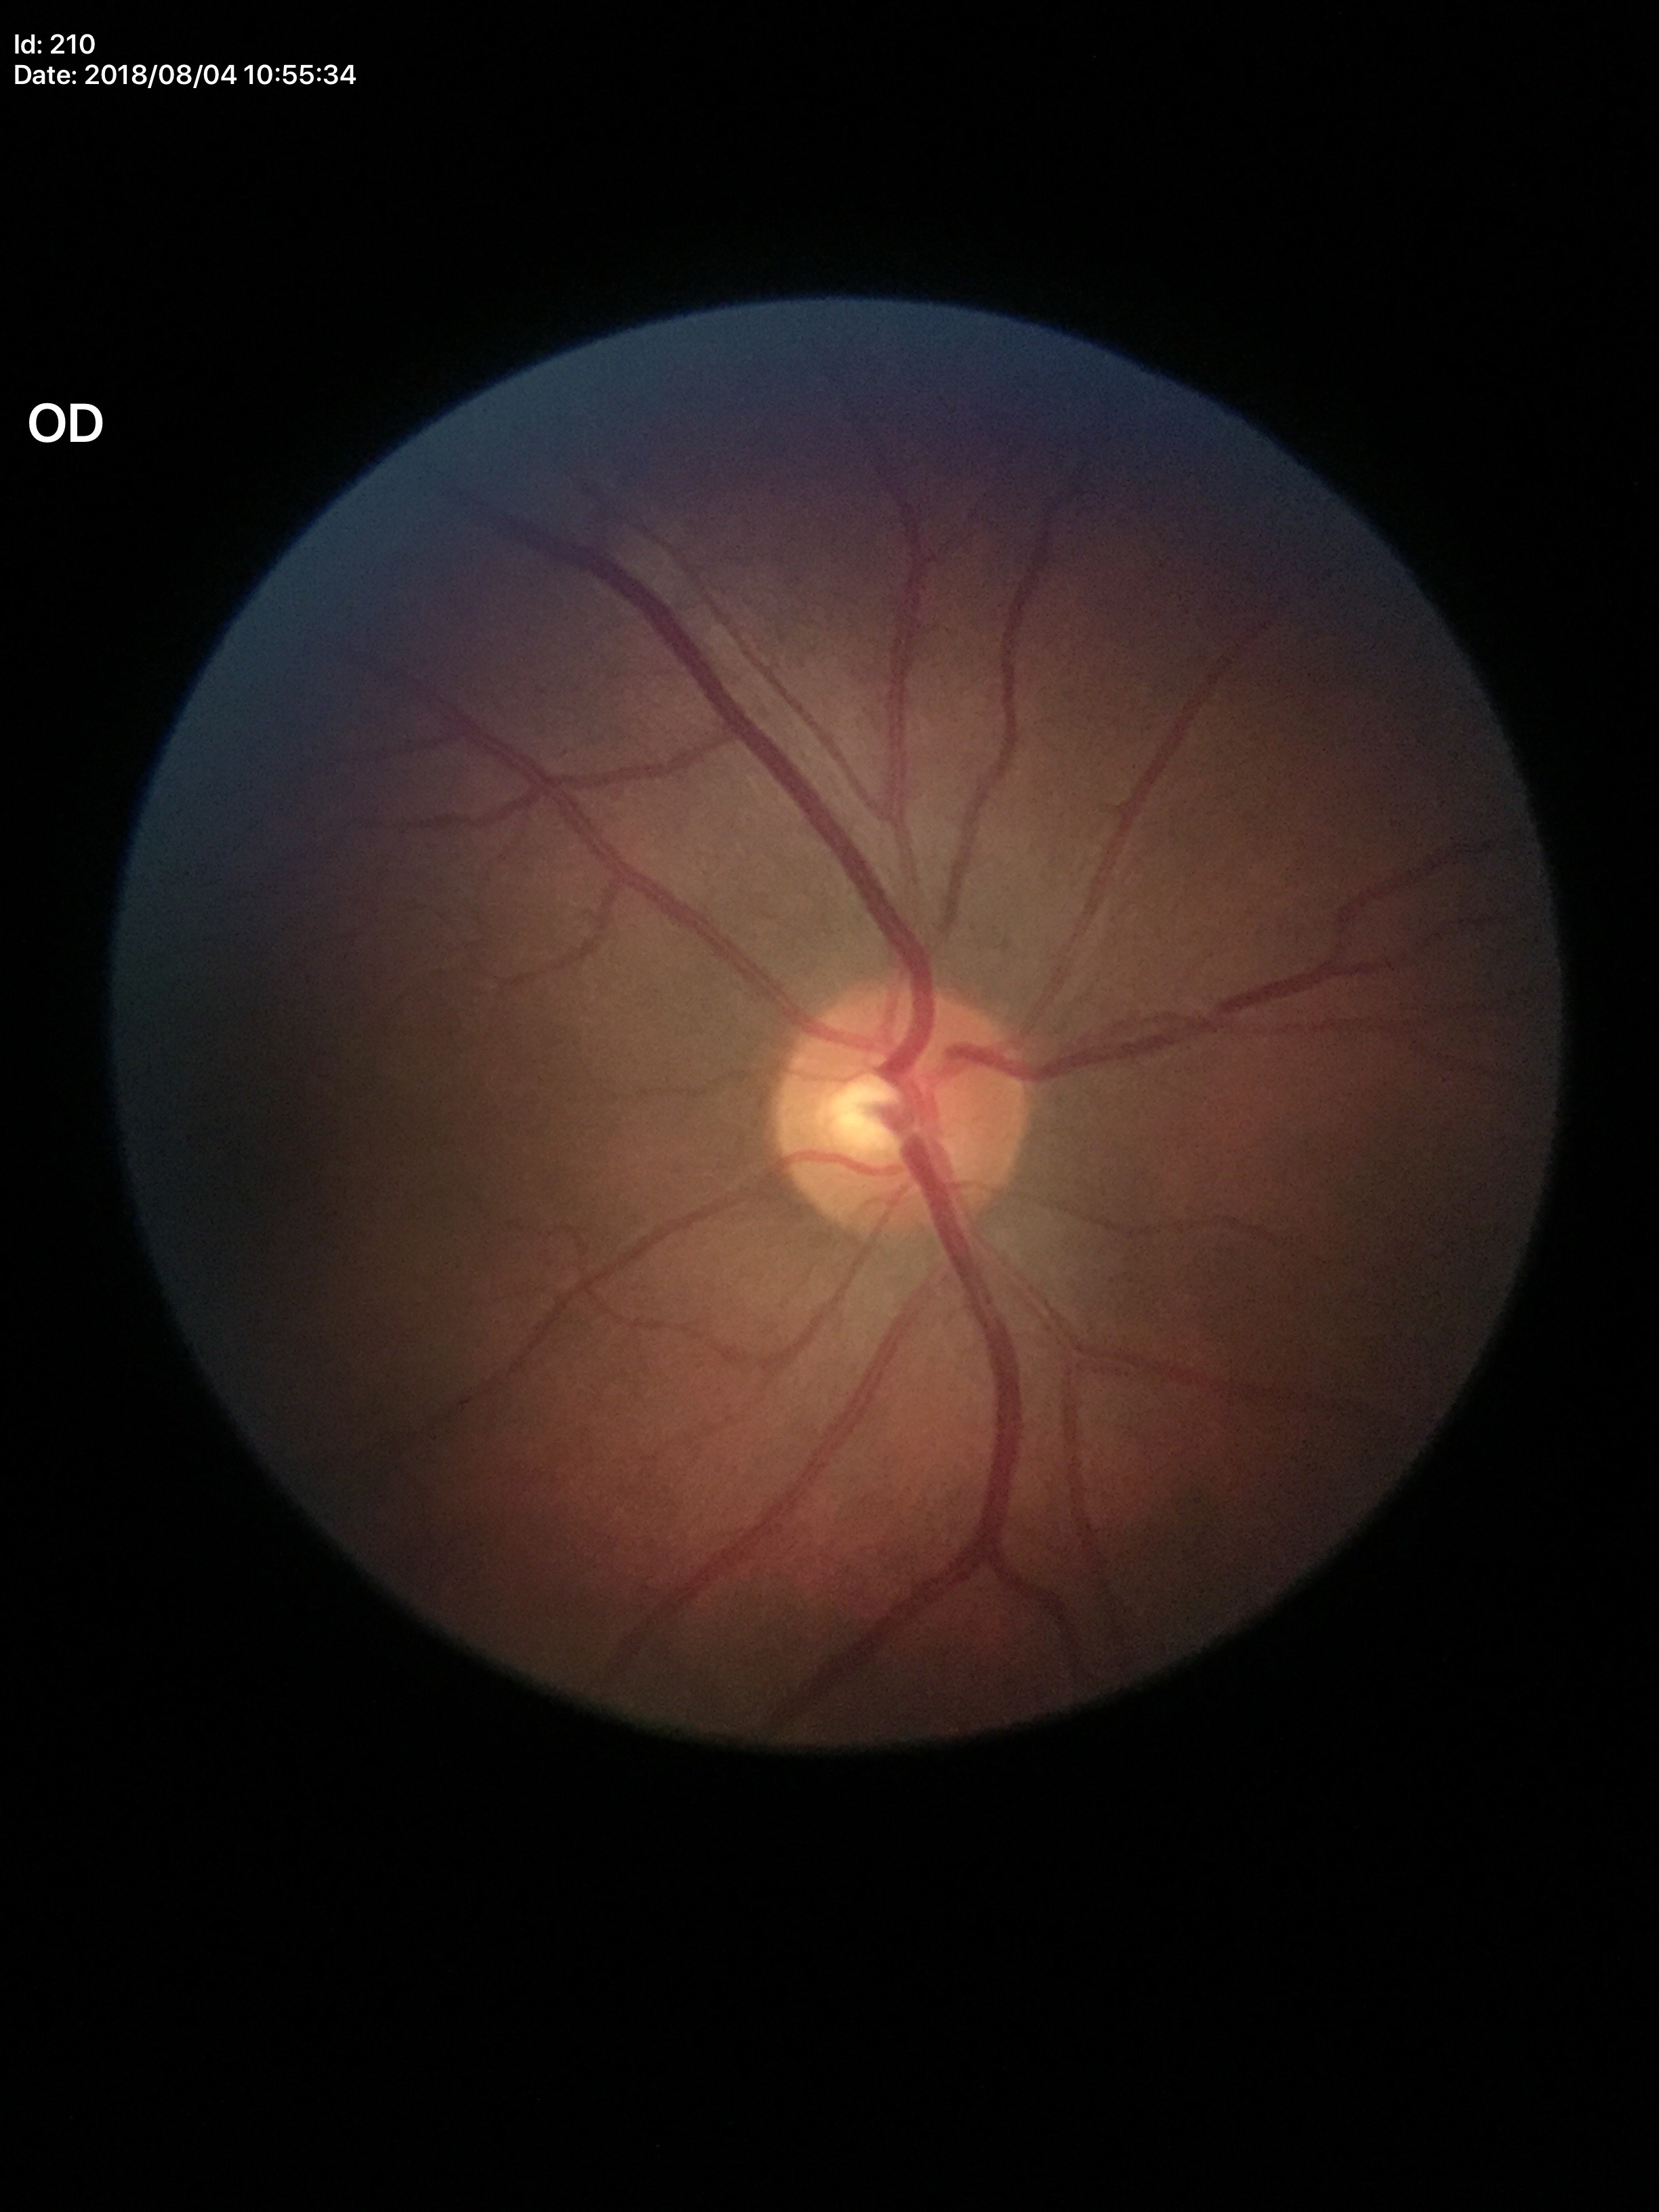
No signs of glaucoma. Vertical C/D ratio: 0.50. Horizontal cup-disc ratio: 0.52.